Topcon TRC-NW8, macula-centered field: 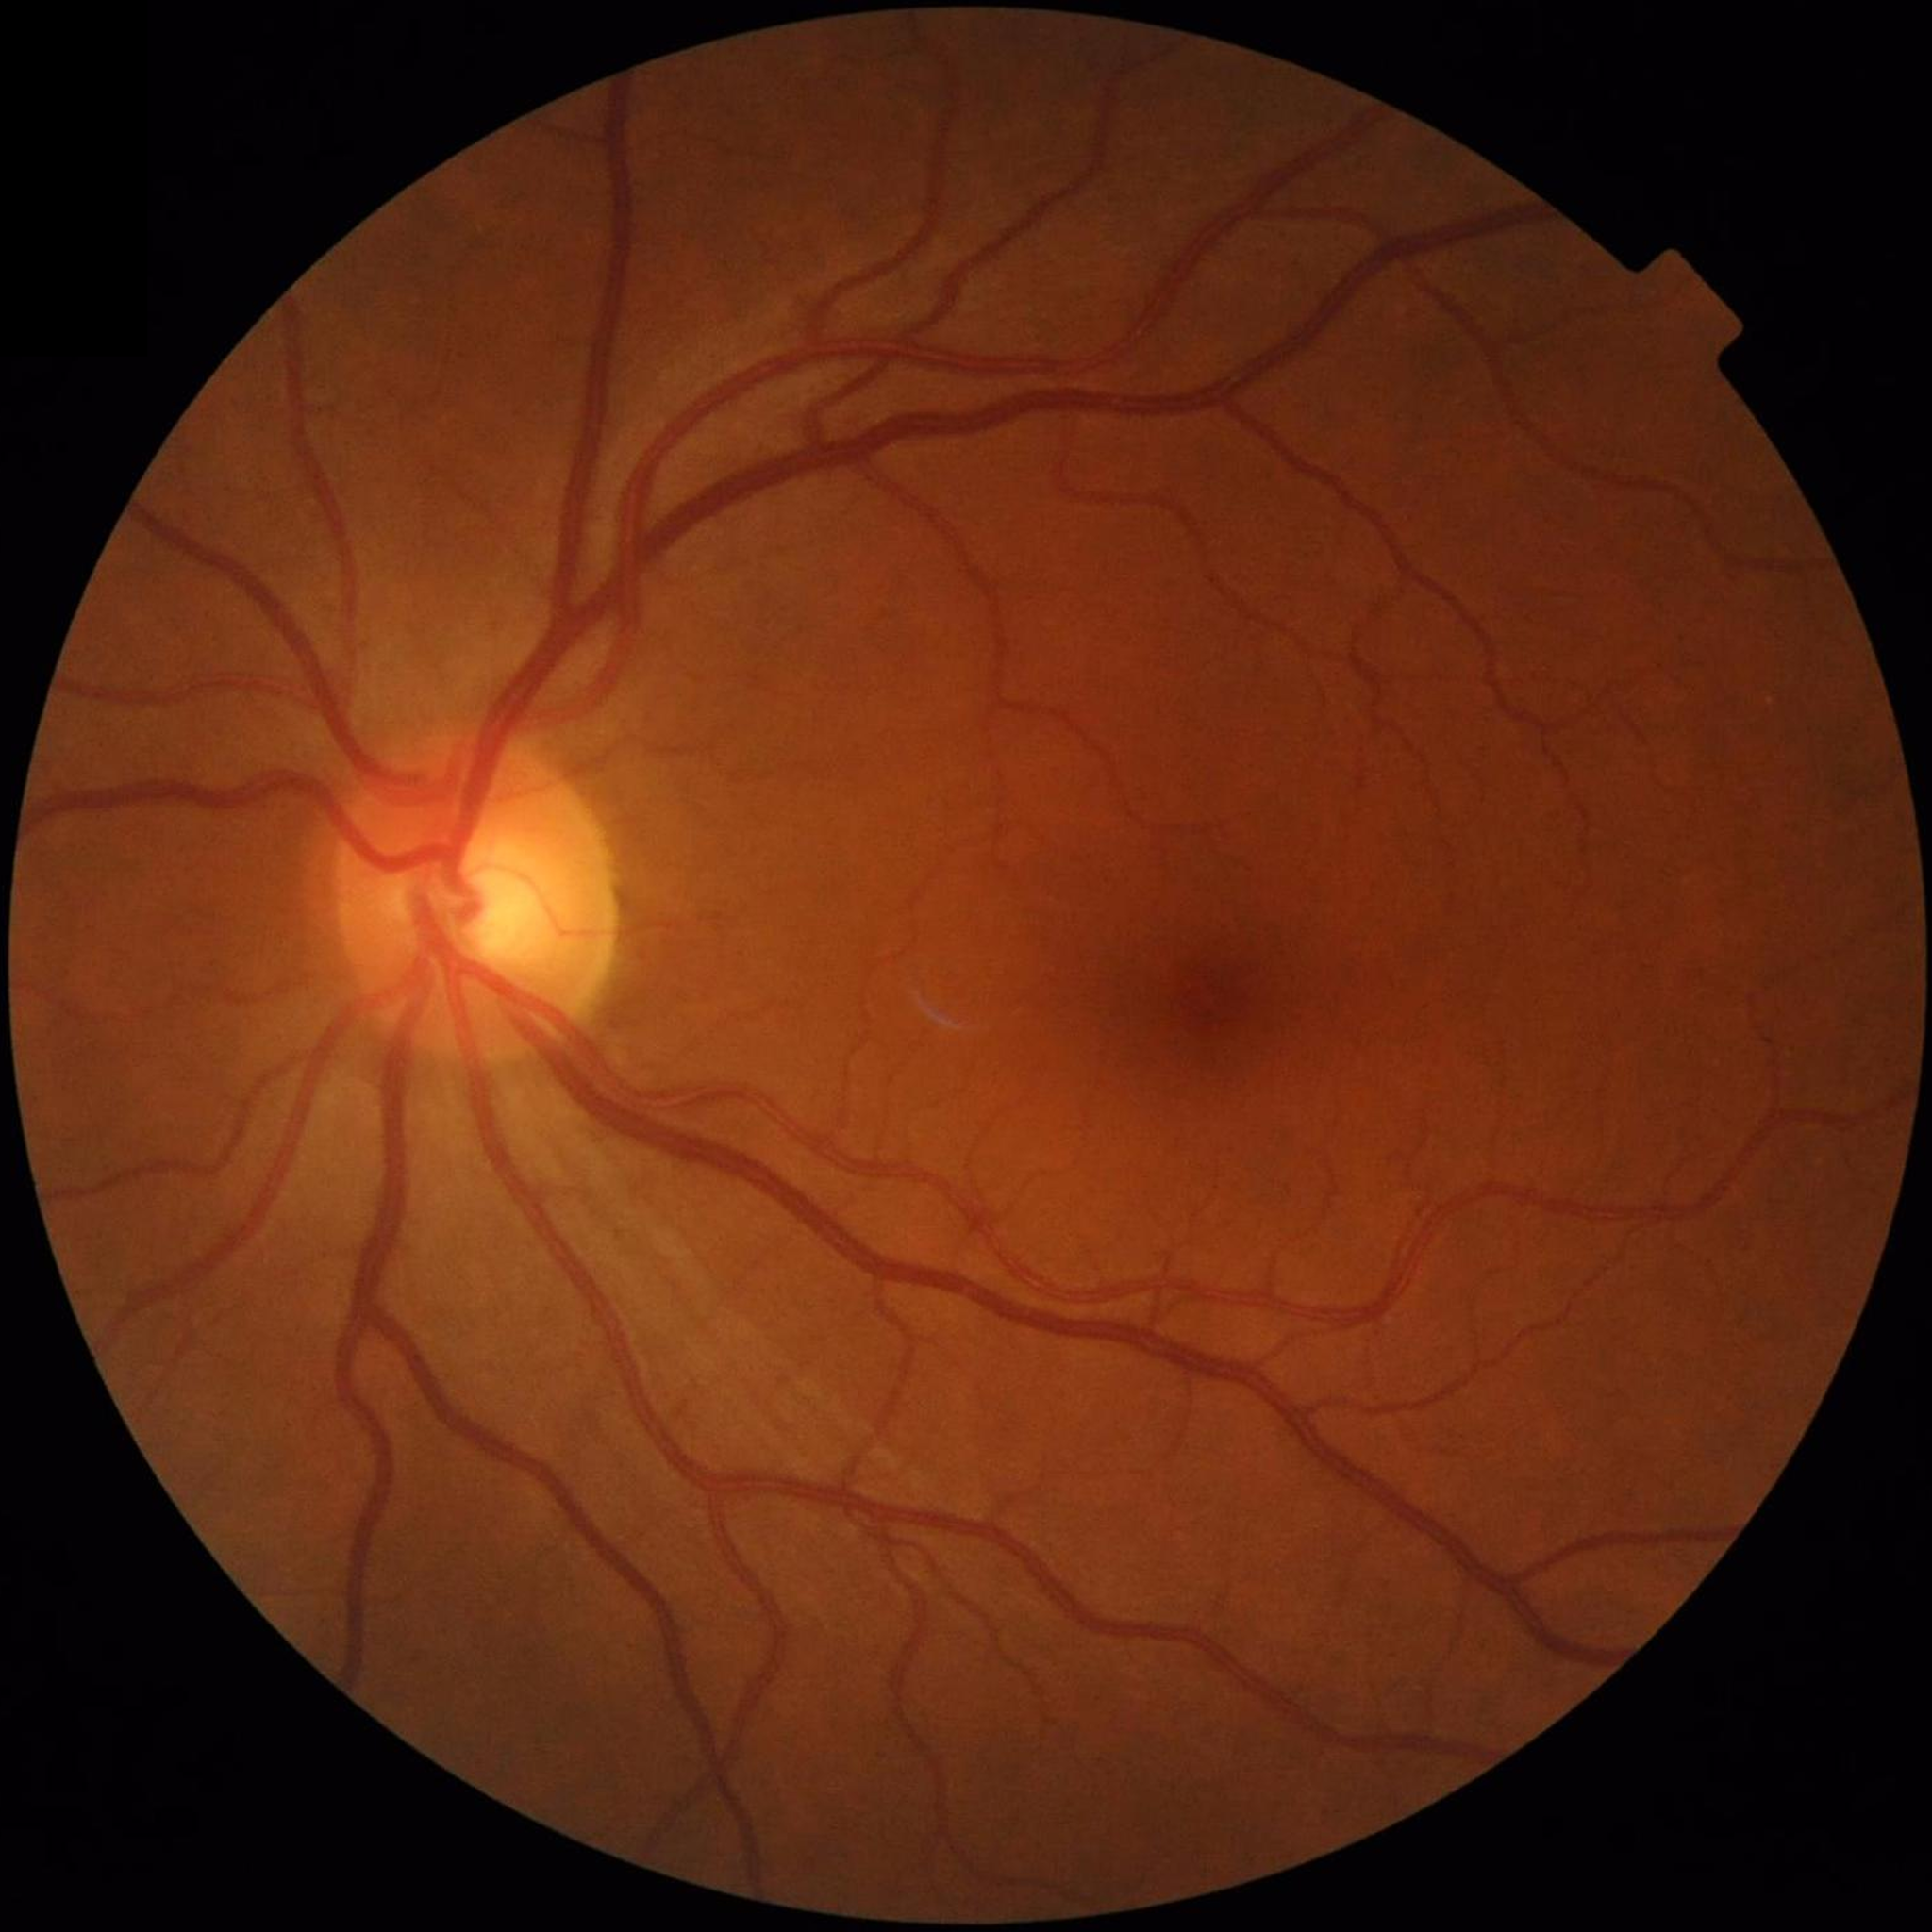

Color fundus photo from a control patient without diagnosed retinal disease.